Camera: Phoenix ICON (100° FOV); wide-field fundus photograph from neonatal ROP screening.
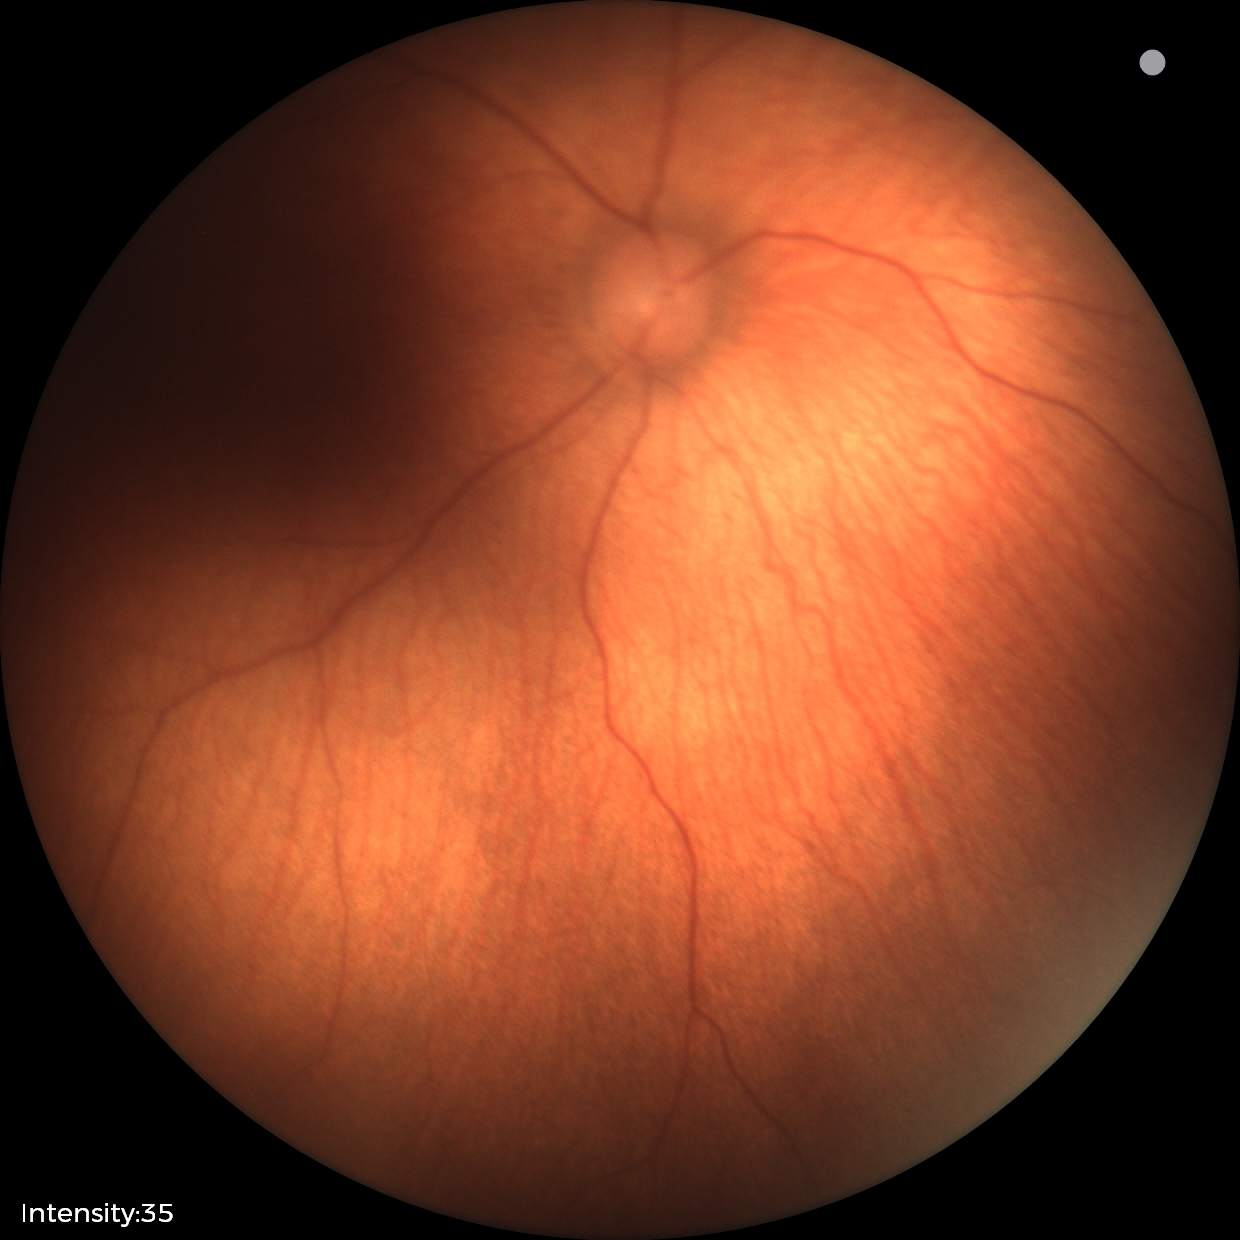
Impression: physiological appearance with no retinal pathology.